Phoenix ICON, 100° FOV; wide-field contact fundus photograph of an infant: 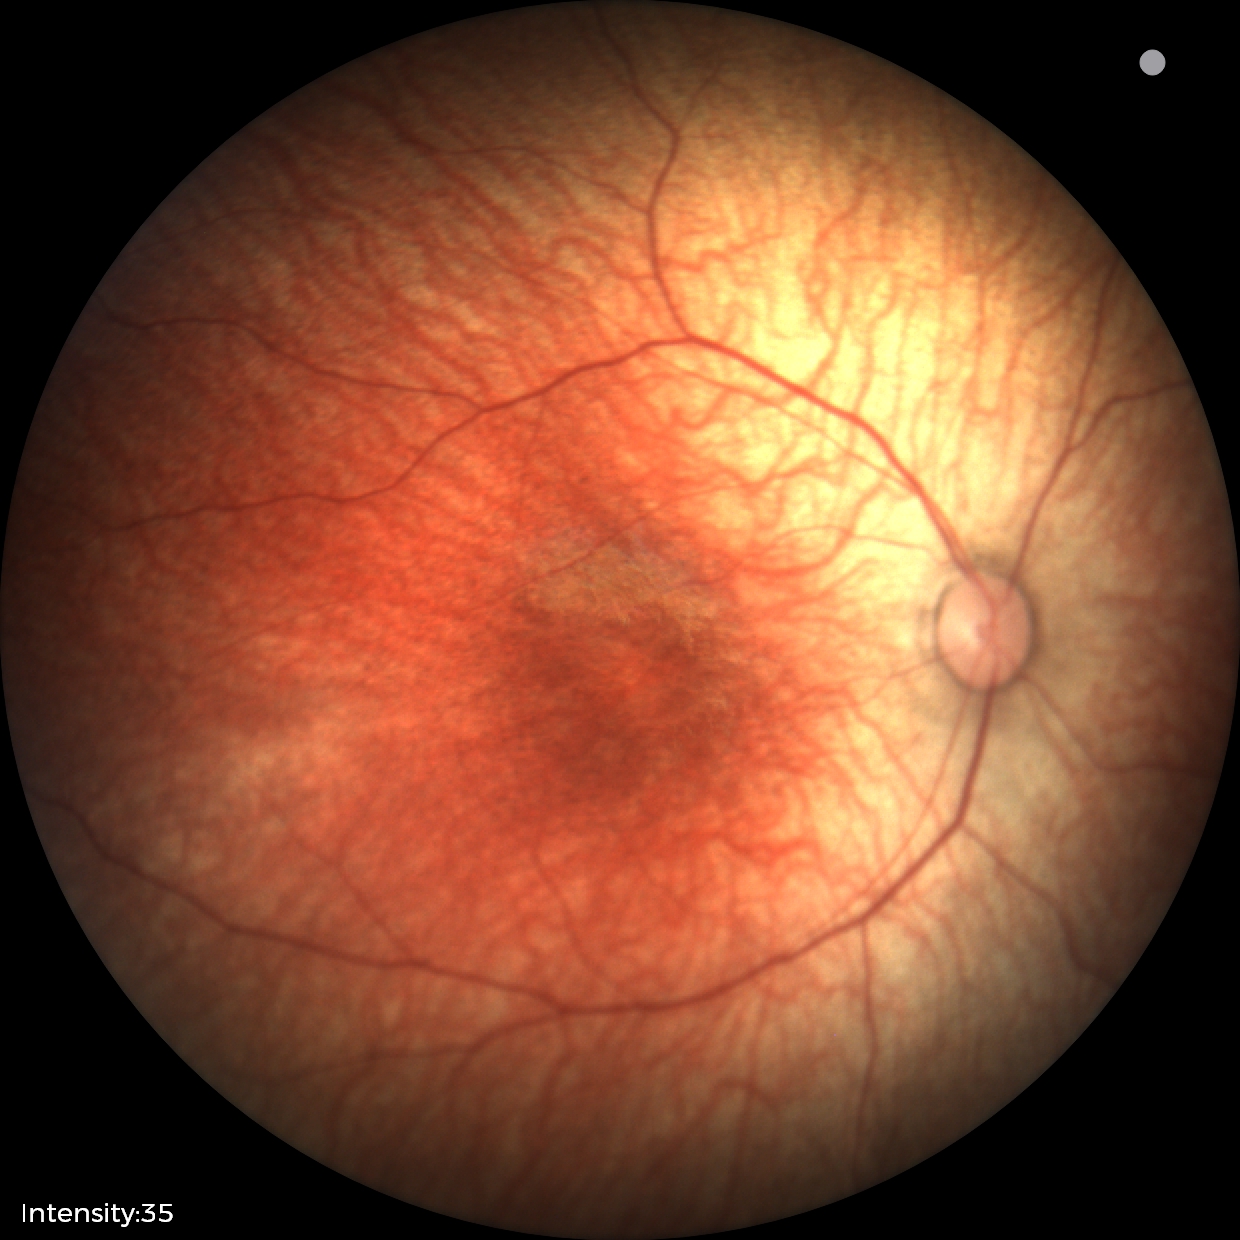
Screening diagnosis: physiological retinal finding.